Color fundus photograph centered on the optic disc.
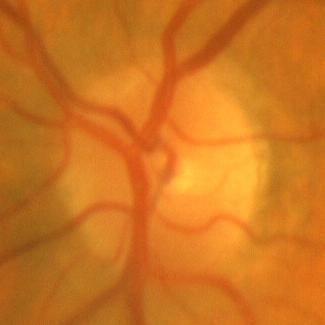
Finding = no glaucomatous changes.